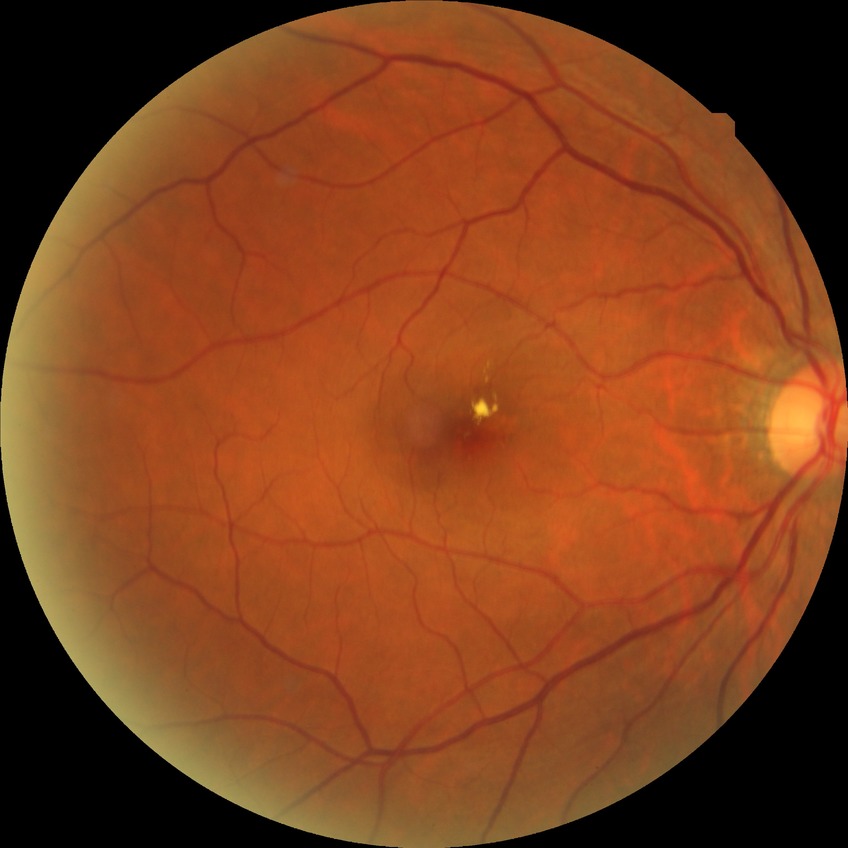
Davis grading: no diabetic retinopathy.